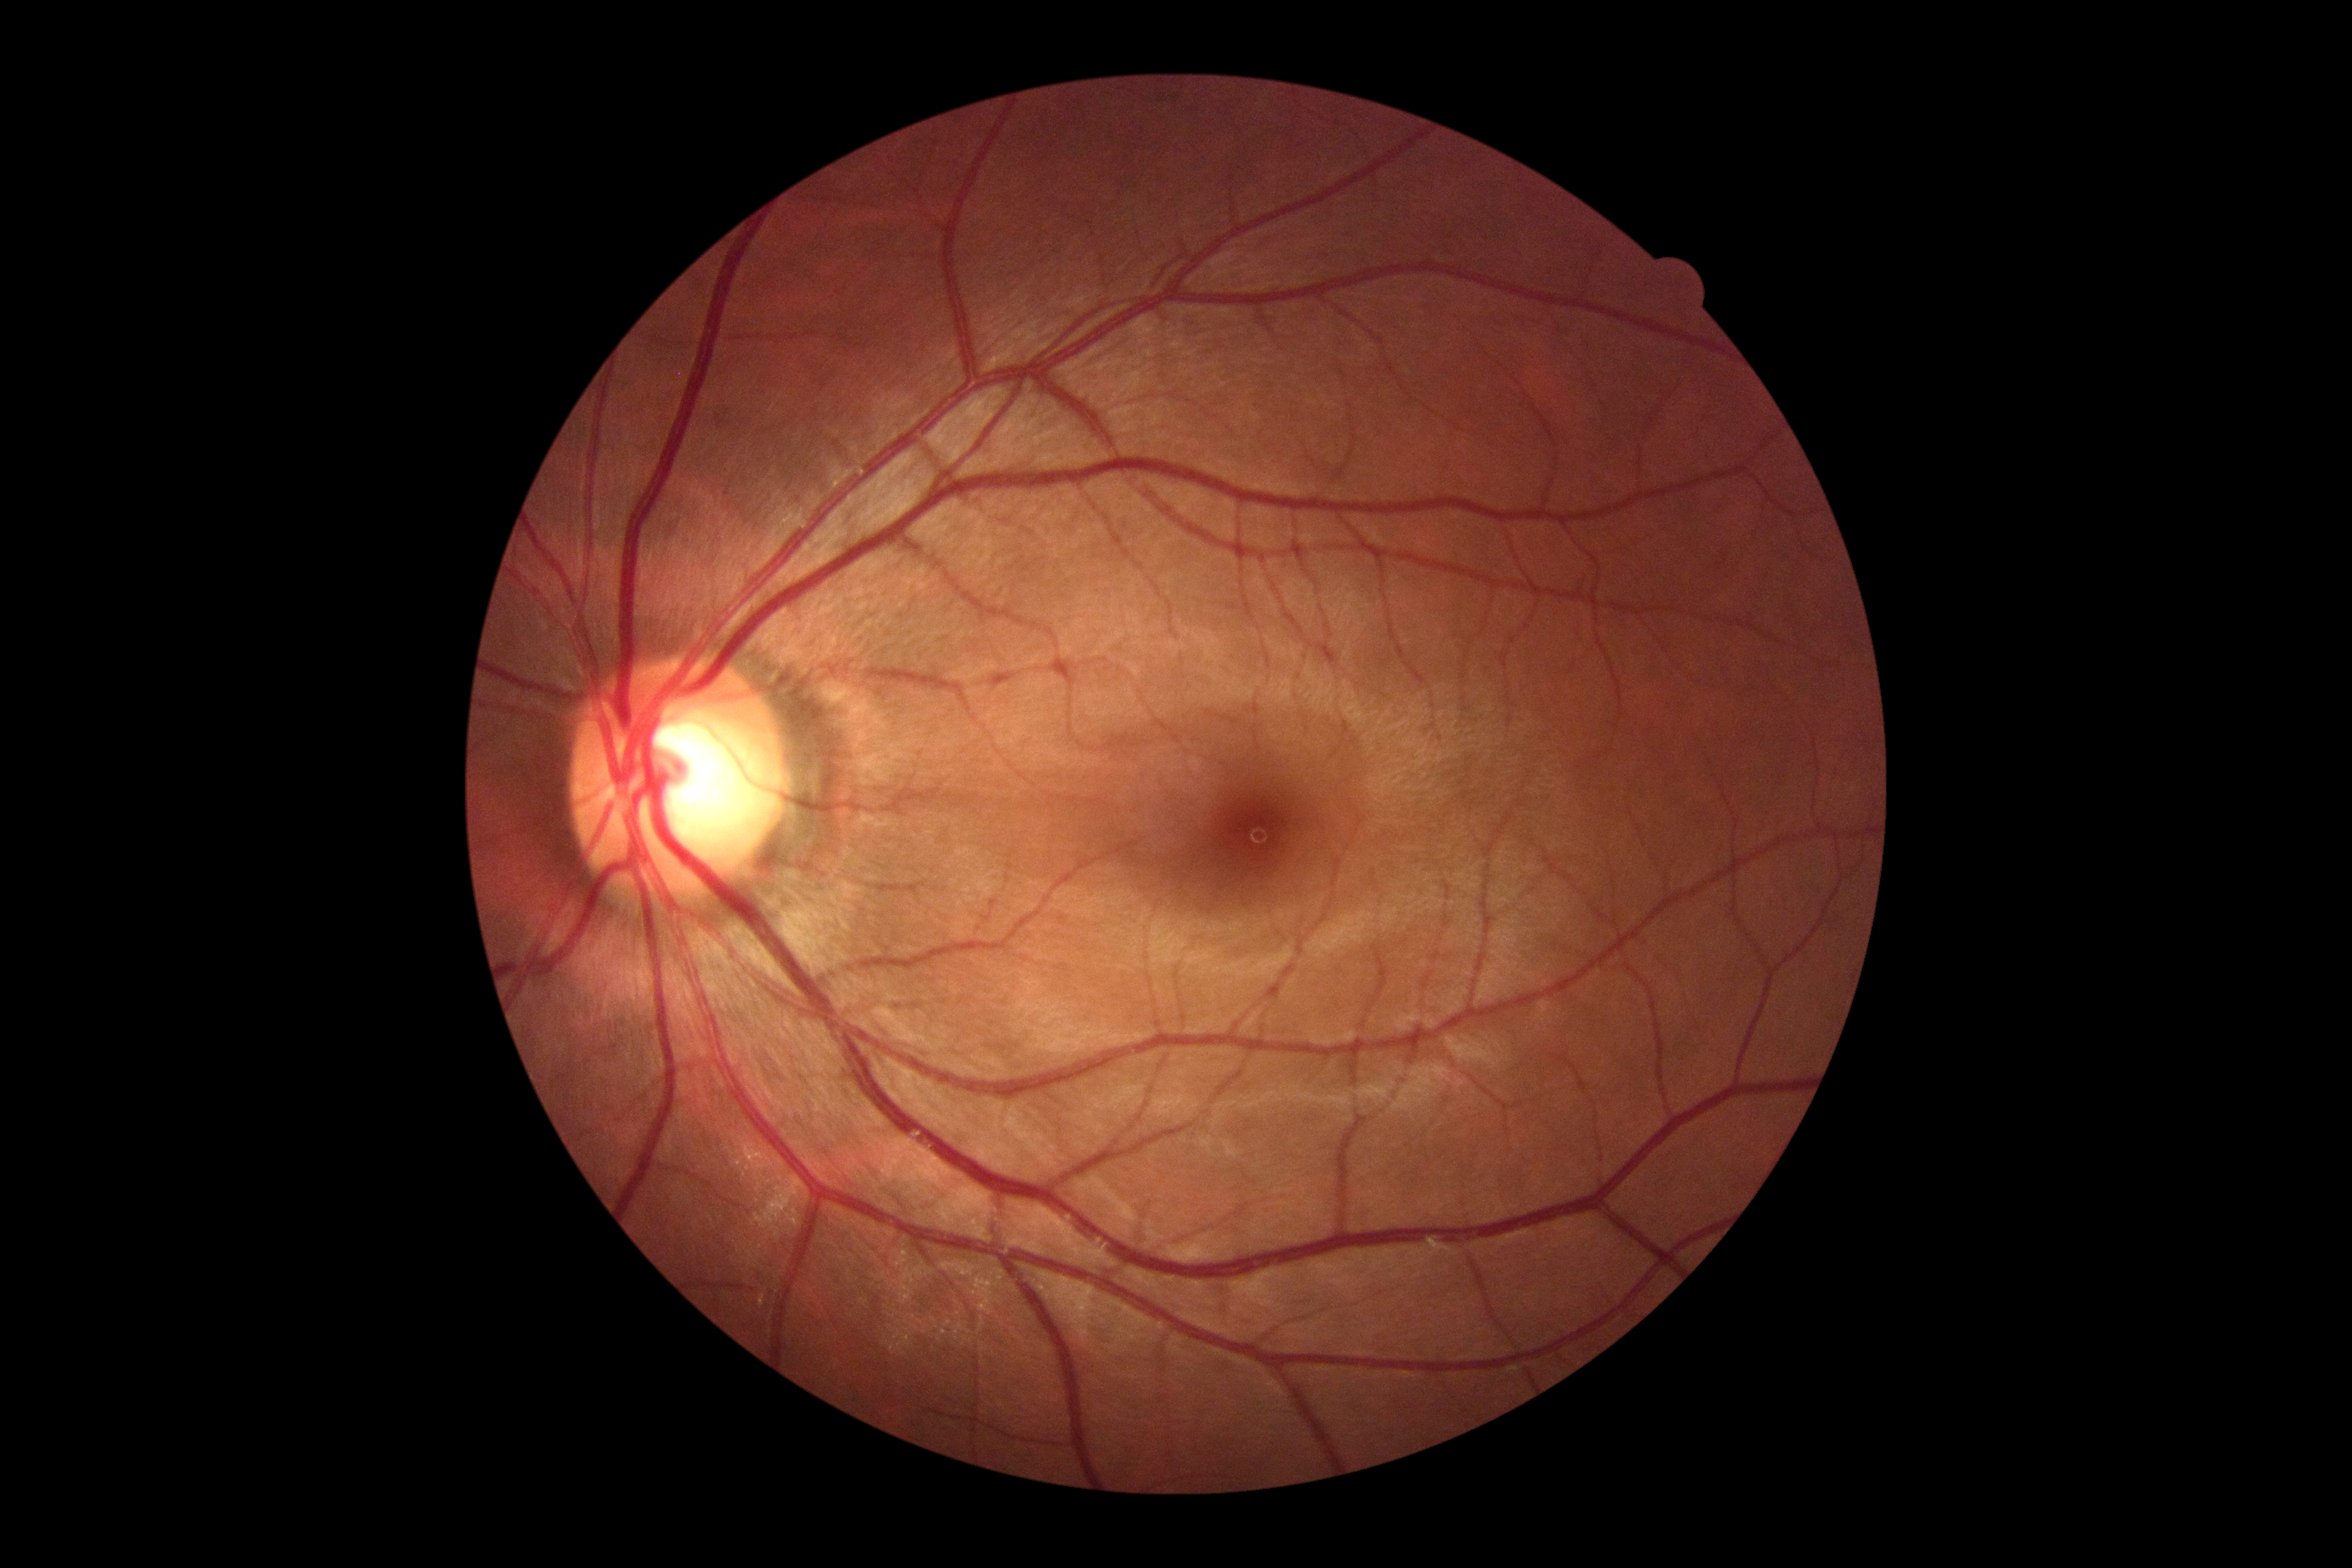

Diabetic retinopathy severity is 0/4.